Infant wide-field fundus photograph:
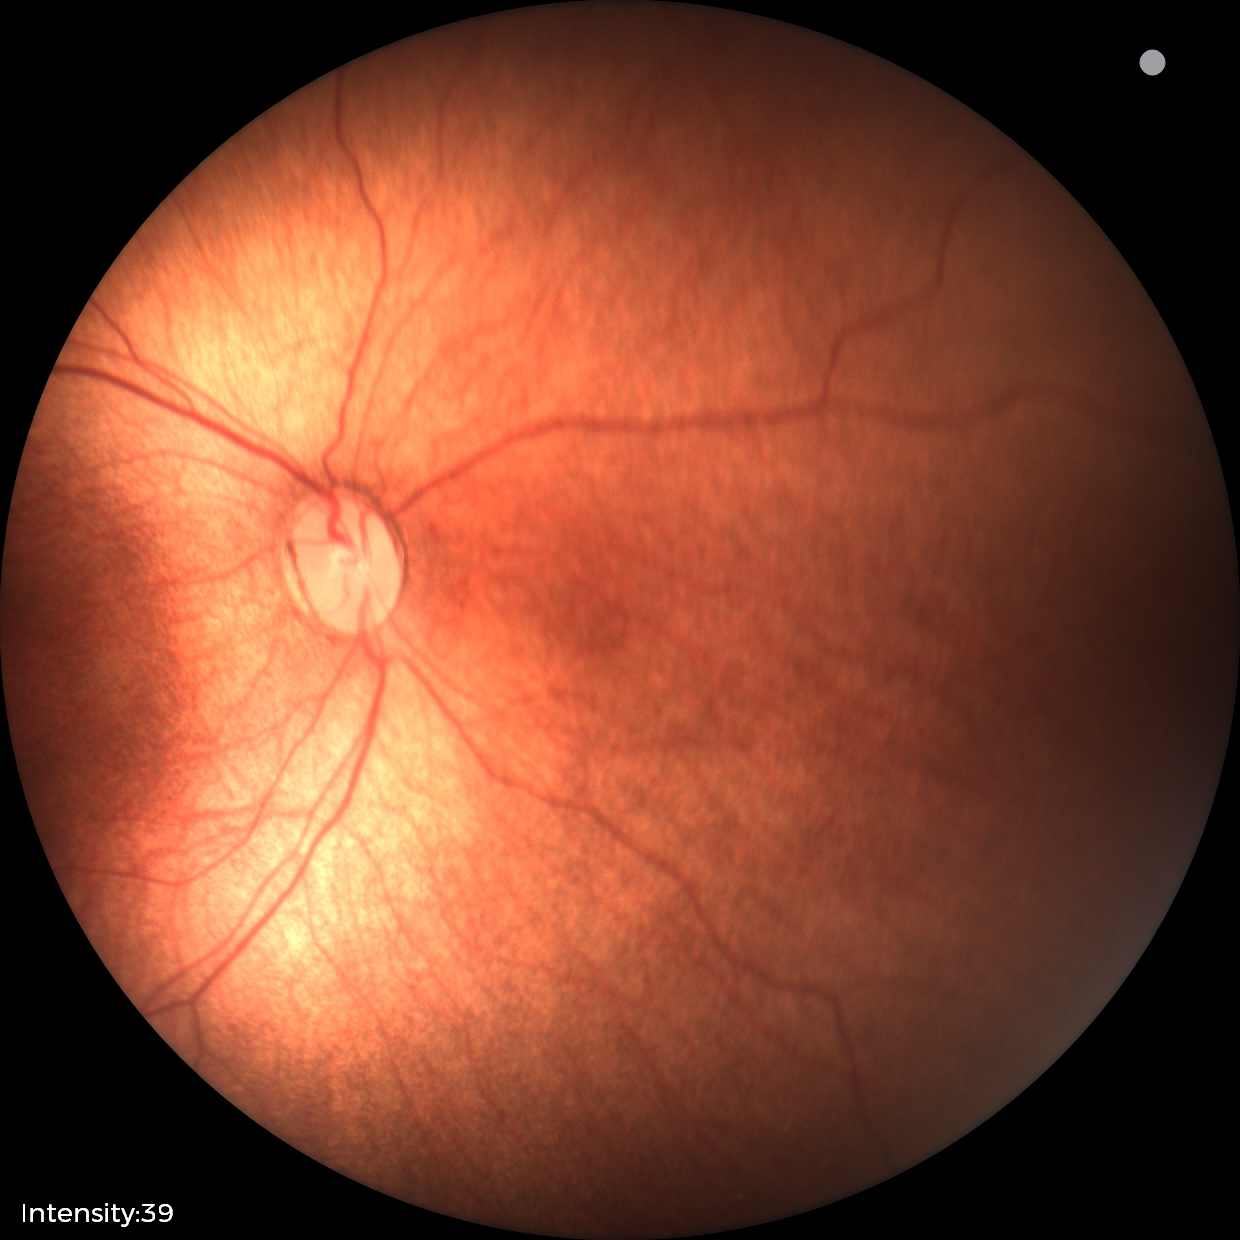

Plus disease absent.
Diagnosis from this screening exam: status post ROP.